Patient age: 66 years · fundus photo · 30-degree field of view
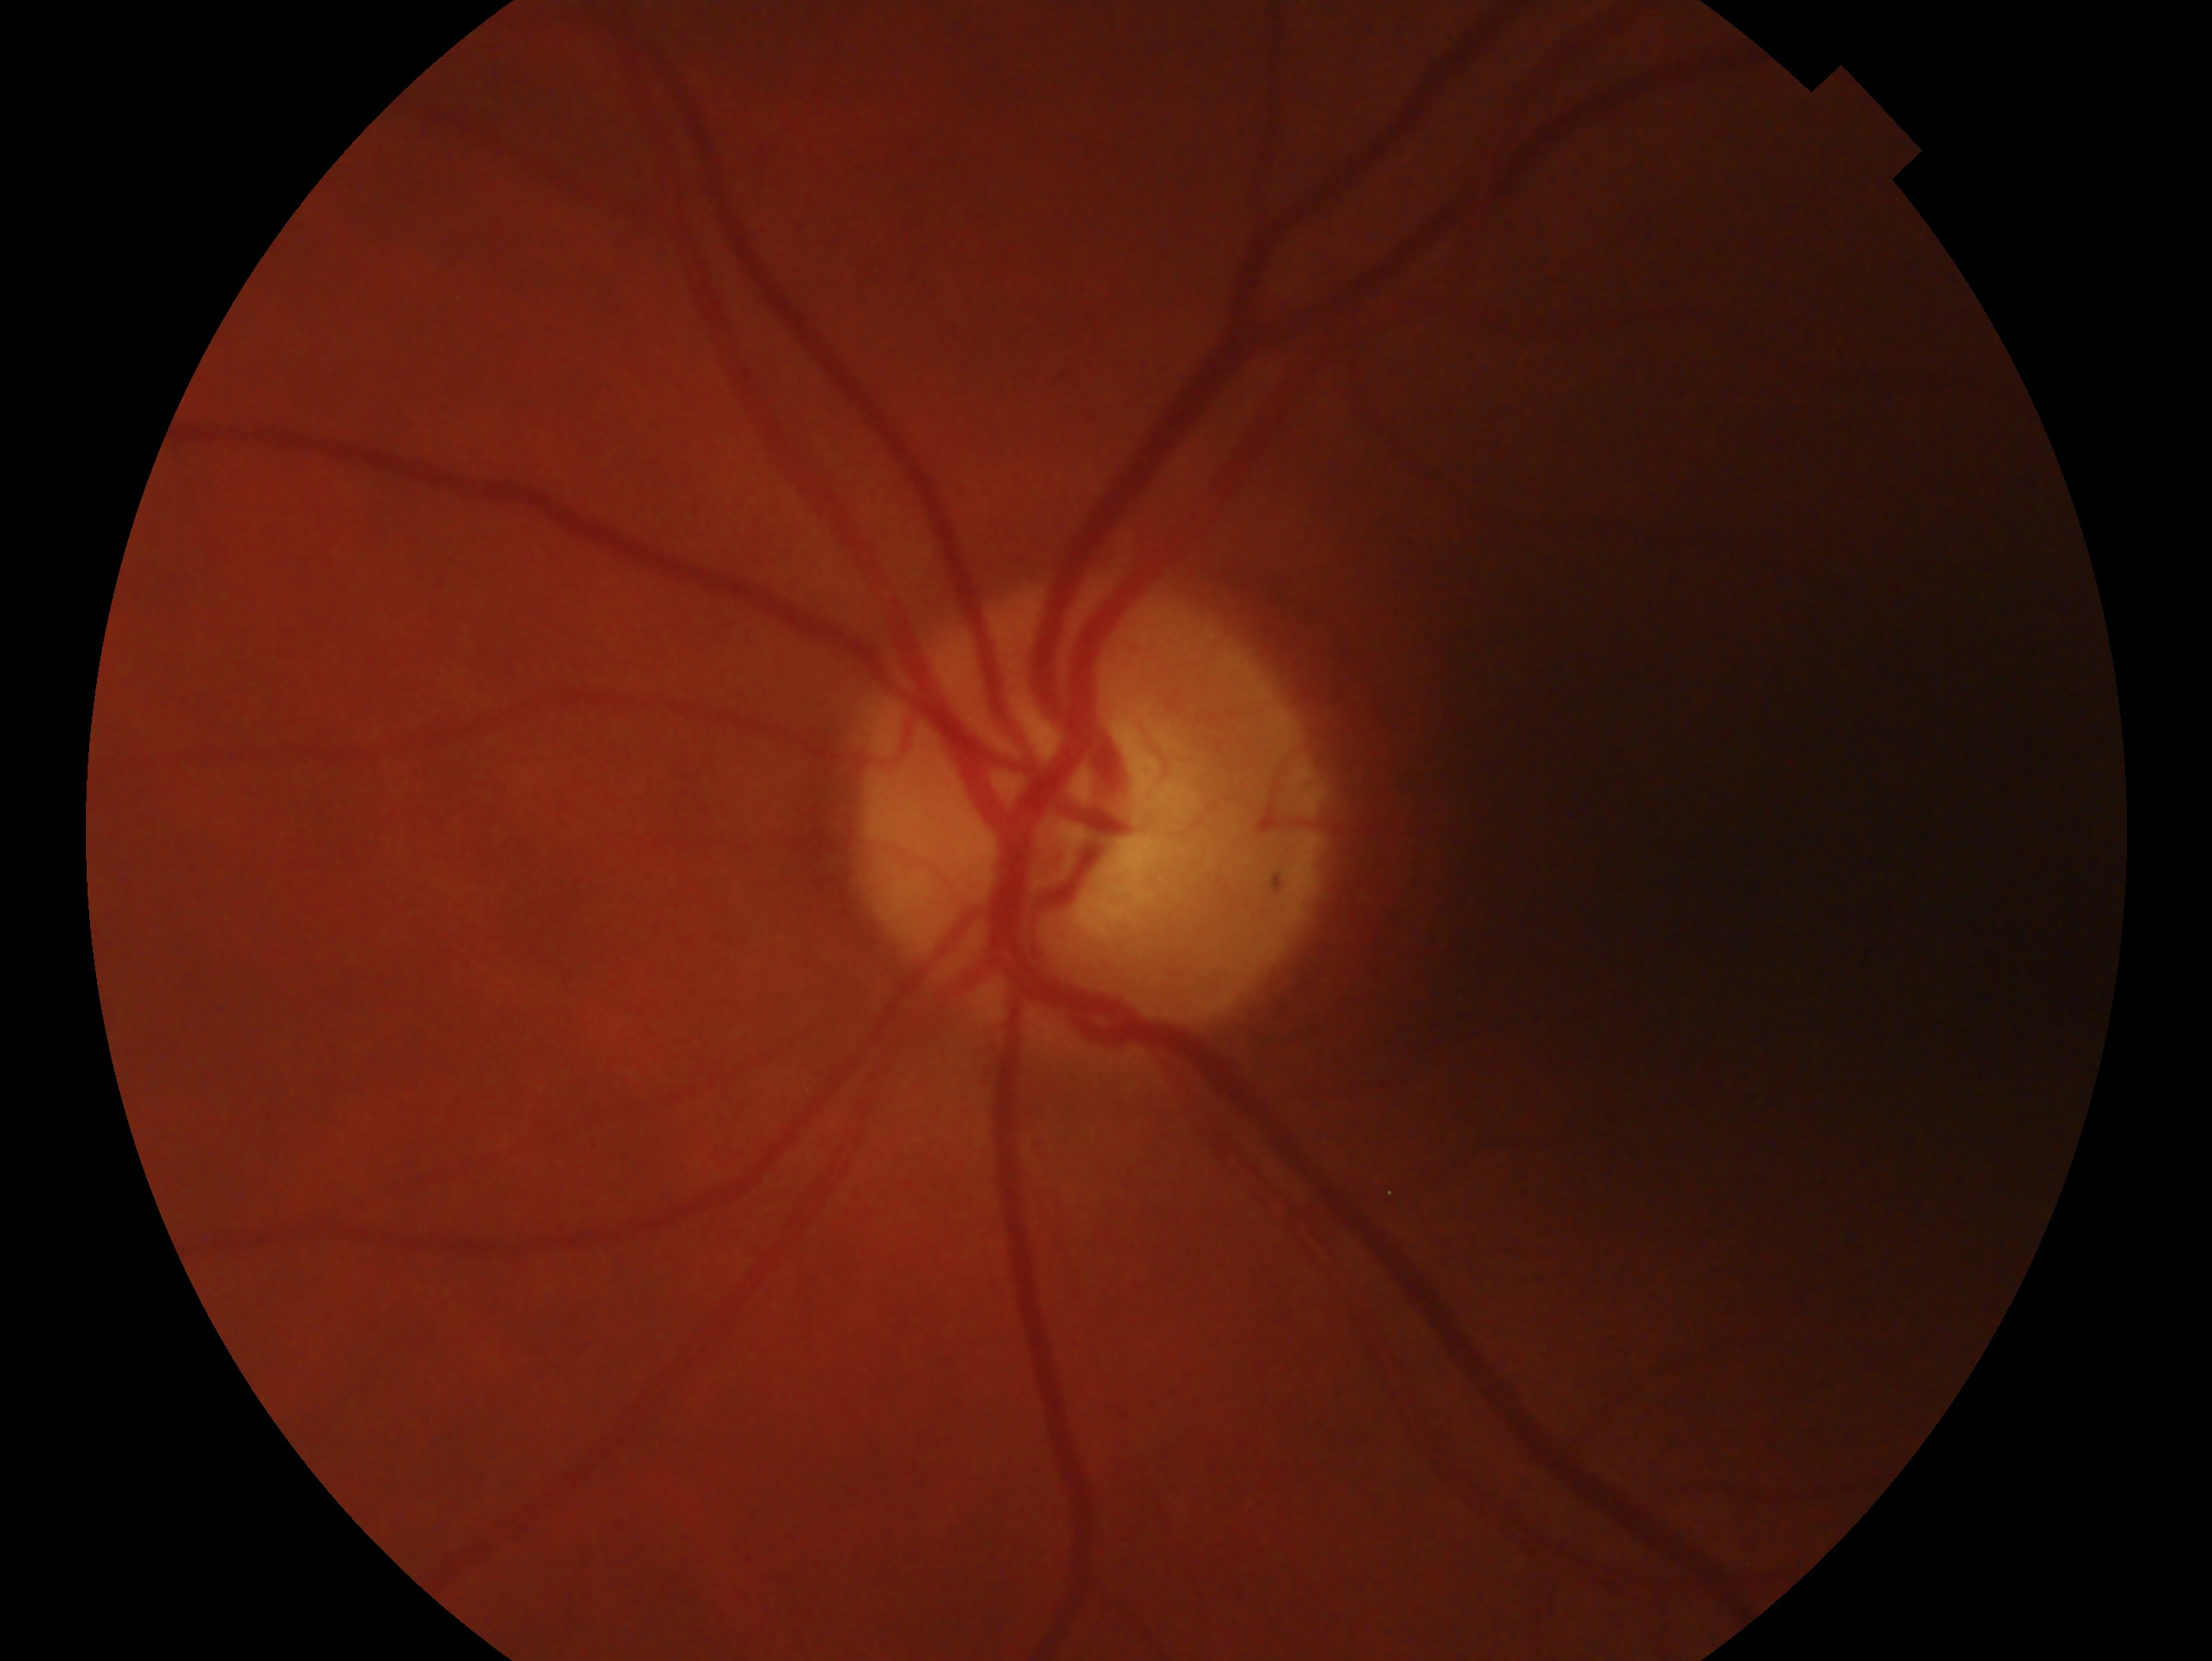
laterality: left; glaucoma status: no glaucoma.